NIDEK AFC-230, modified Davis classification
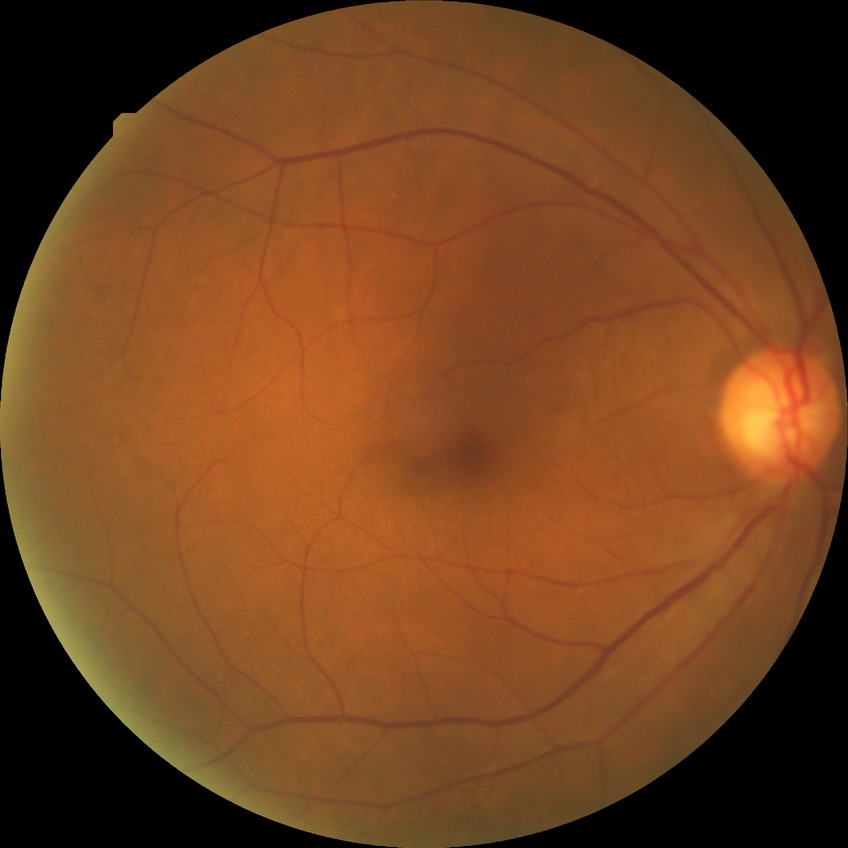 {
  "davis_grade": "no diabetic retinopathy"
}